FOV: 45 degrees — 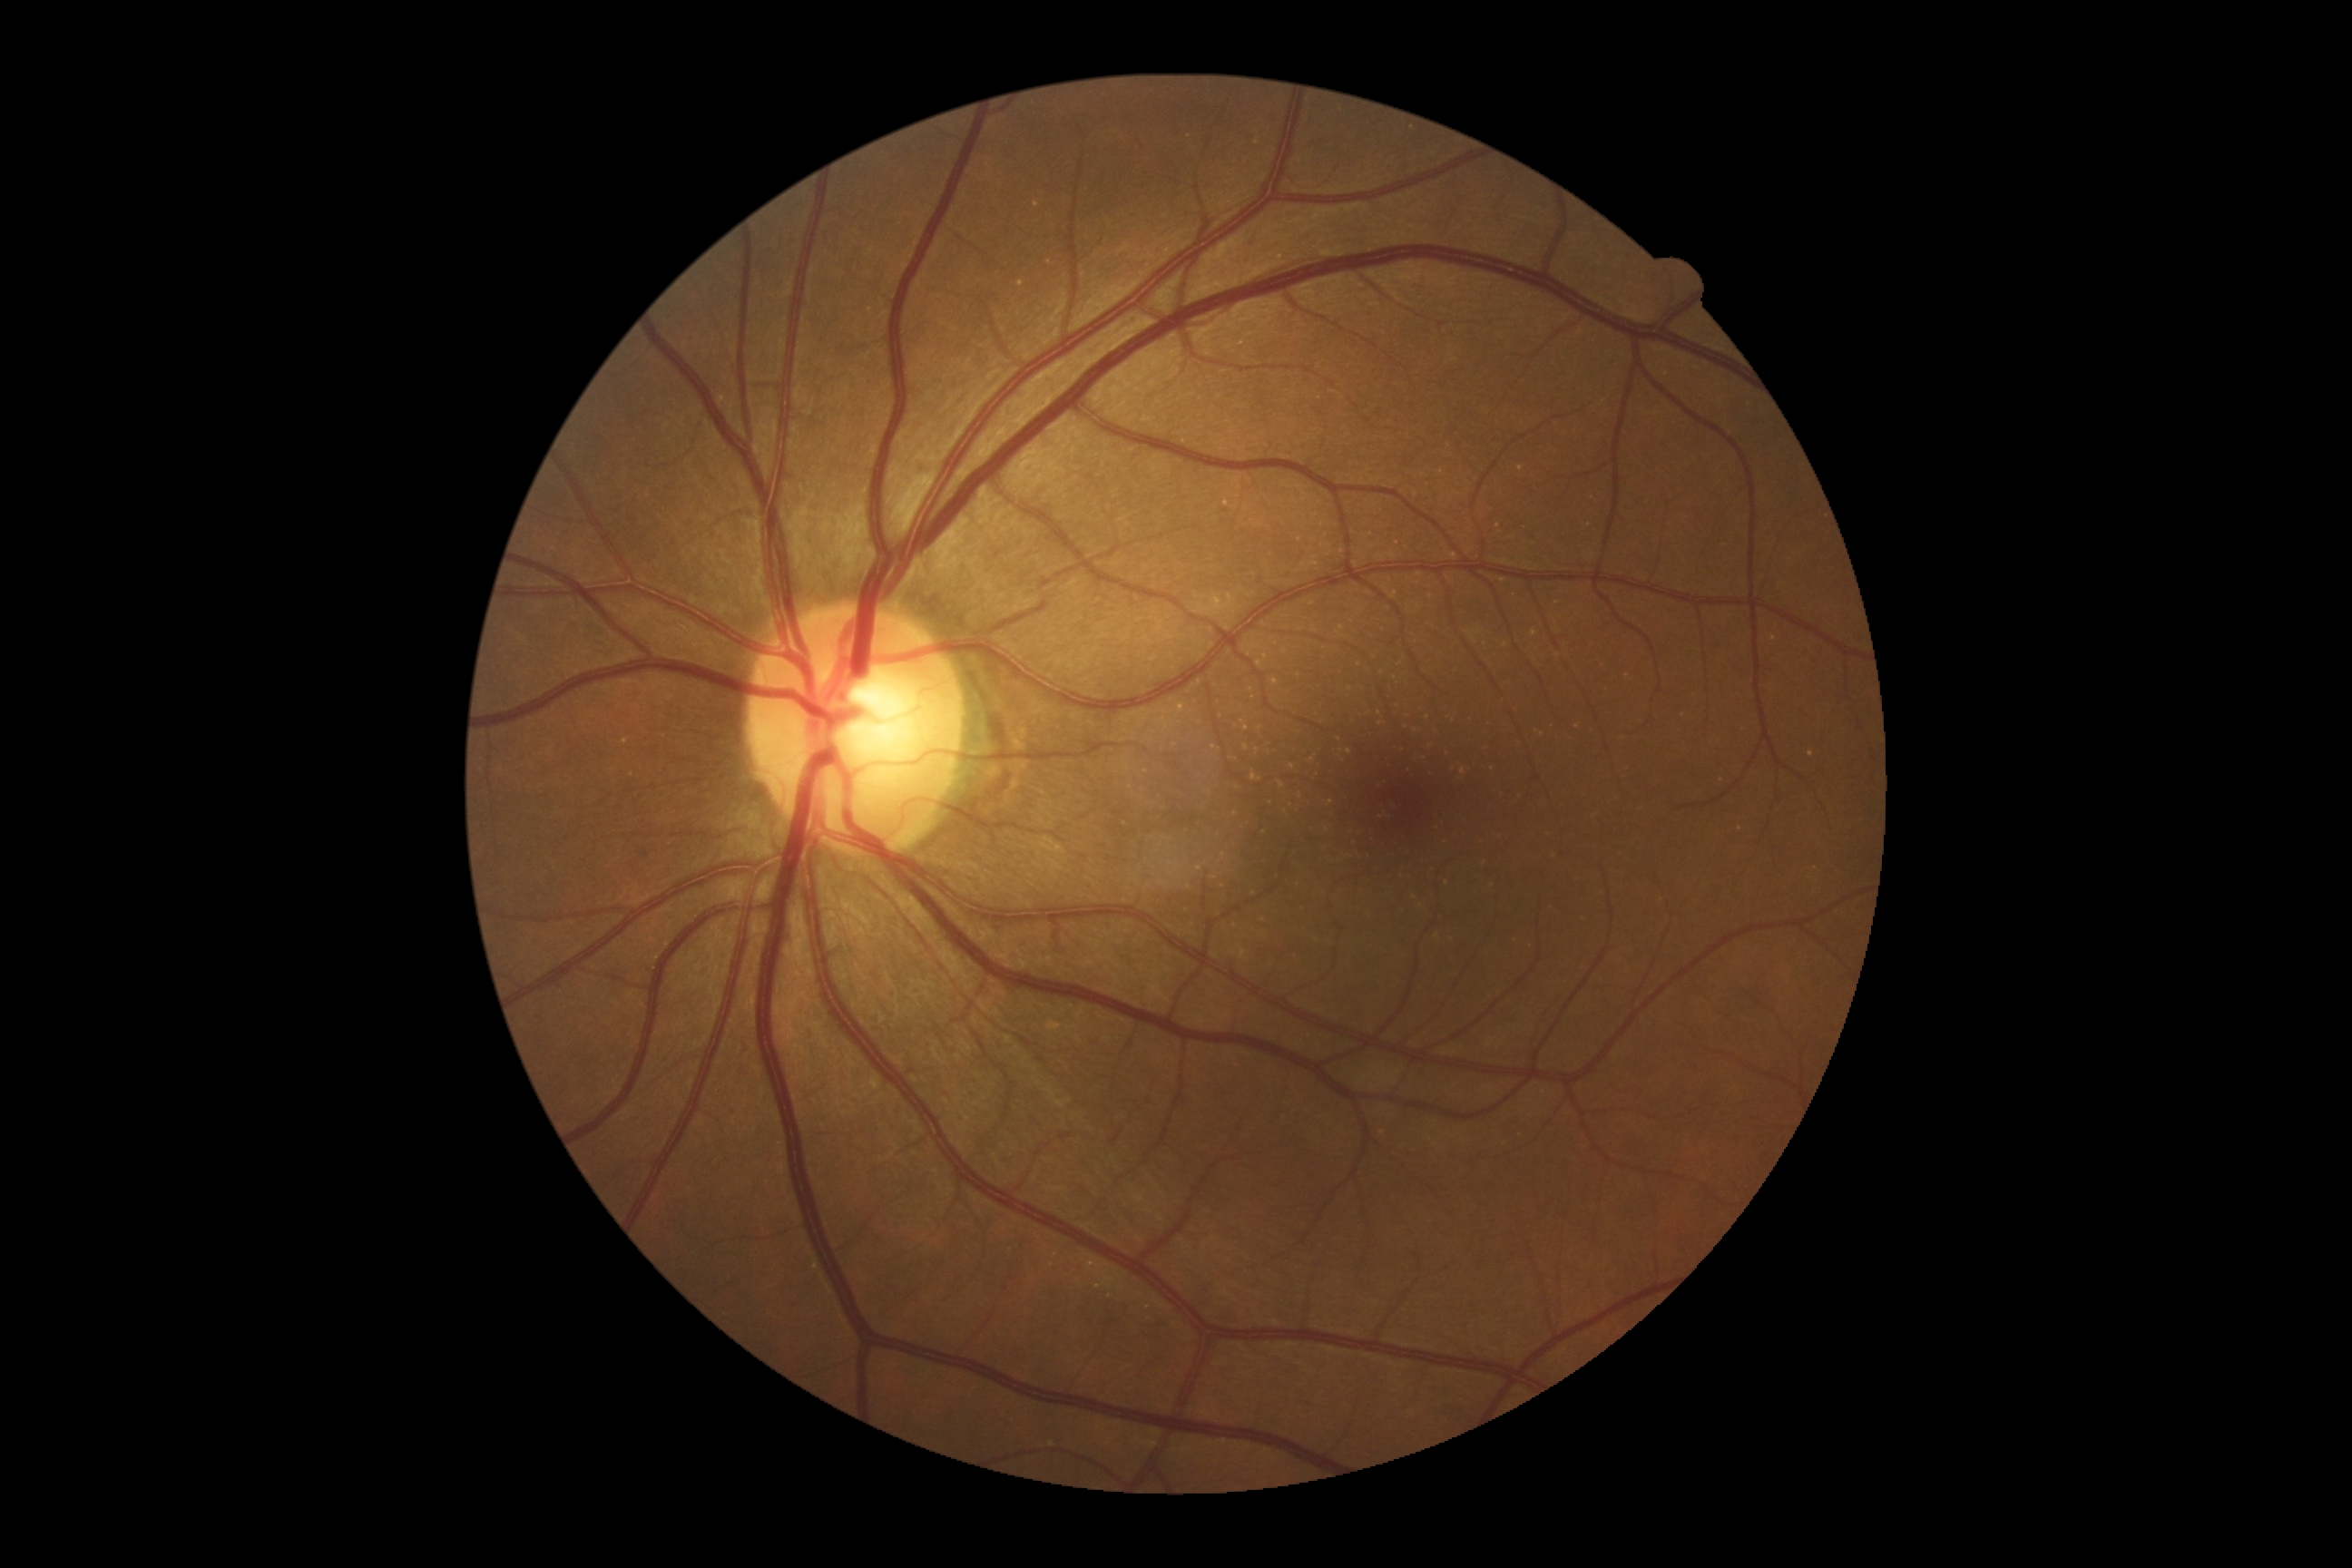
No signs of diabetic retinopathy. Diabetic retinopathy (DR) is grade 0 (no apparent retinopathy).